240 x 240 pixels:
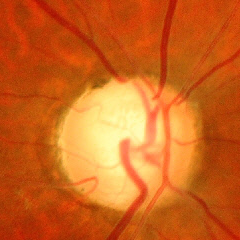 Glaucoma assessment: advanced glaucomatous optic neuropathy.